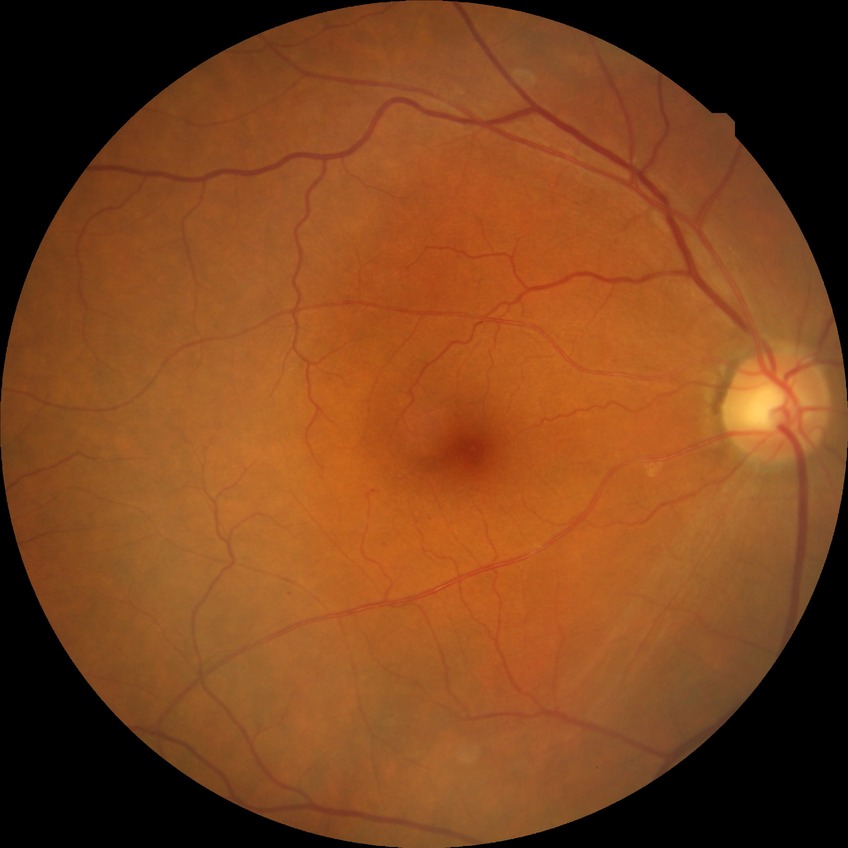 Diabetic retinopathy (DR): simple diabetic retinopathy (SDR).